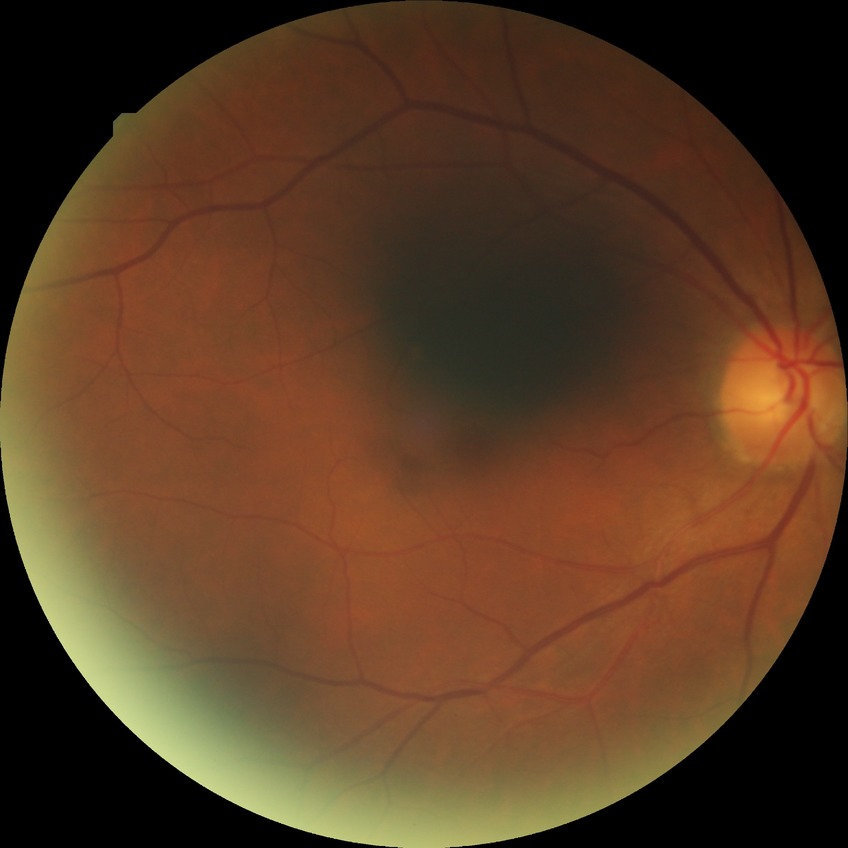
Davis stage: NDR.